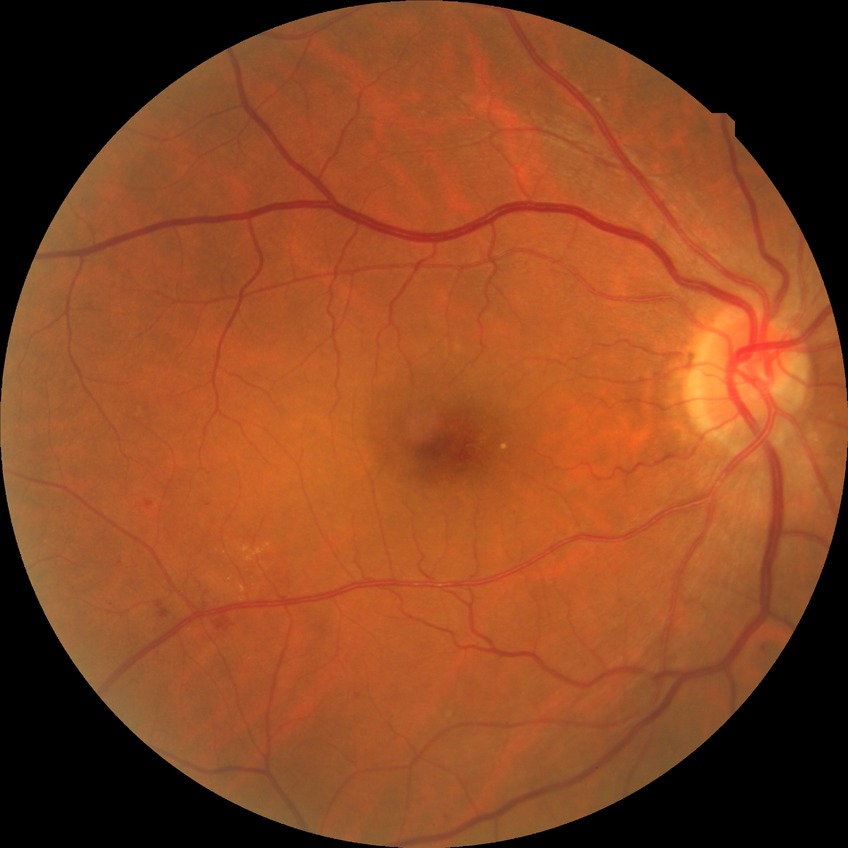 Diabetic retinopathy (DR): SDR (simple diabetic retinopathy).